200° field of view. Ultra-widefield (UWF) fundus image. 1924x1556px — 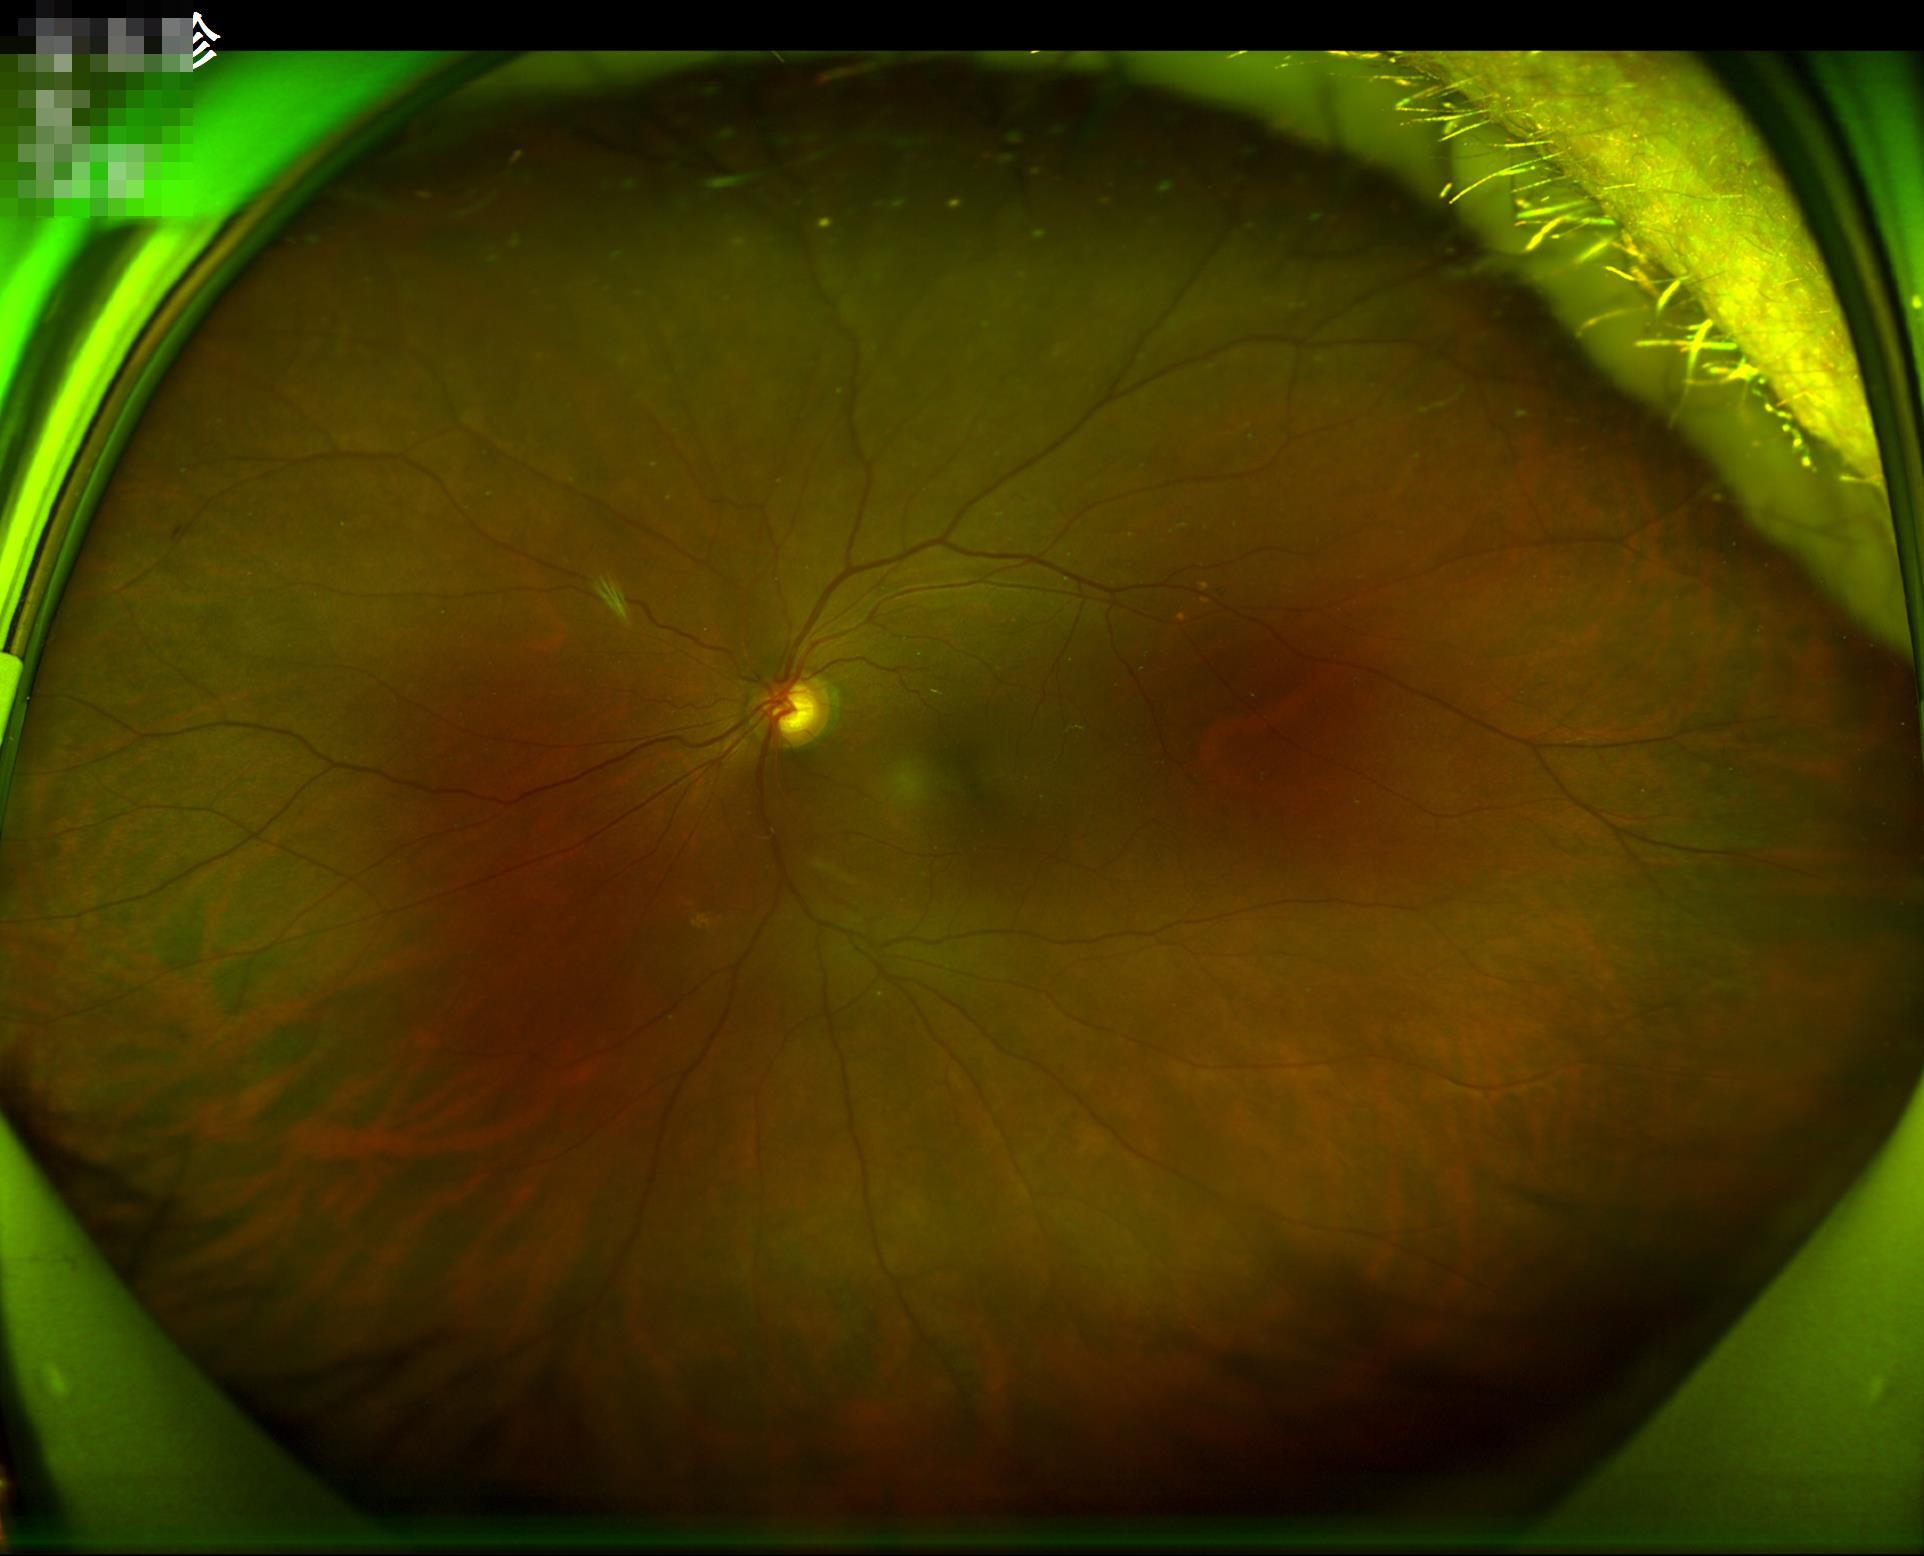

  clarity: good
  overall_quality: satisfactory
  illumination: adequate